Color fundus photograph from a handheld portable camera — 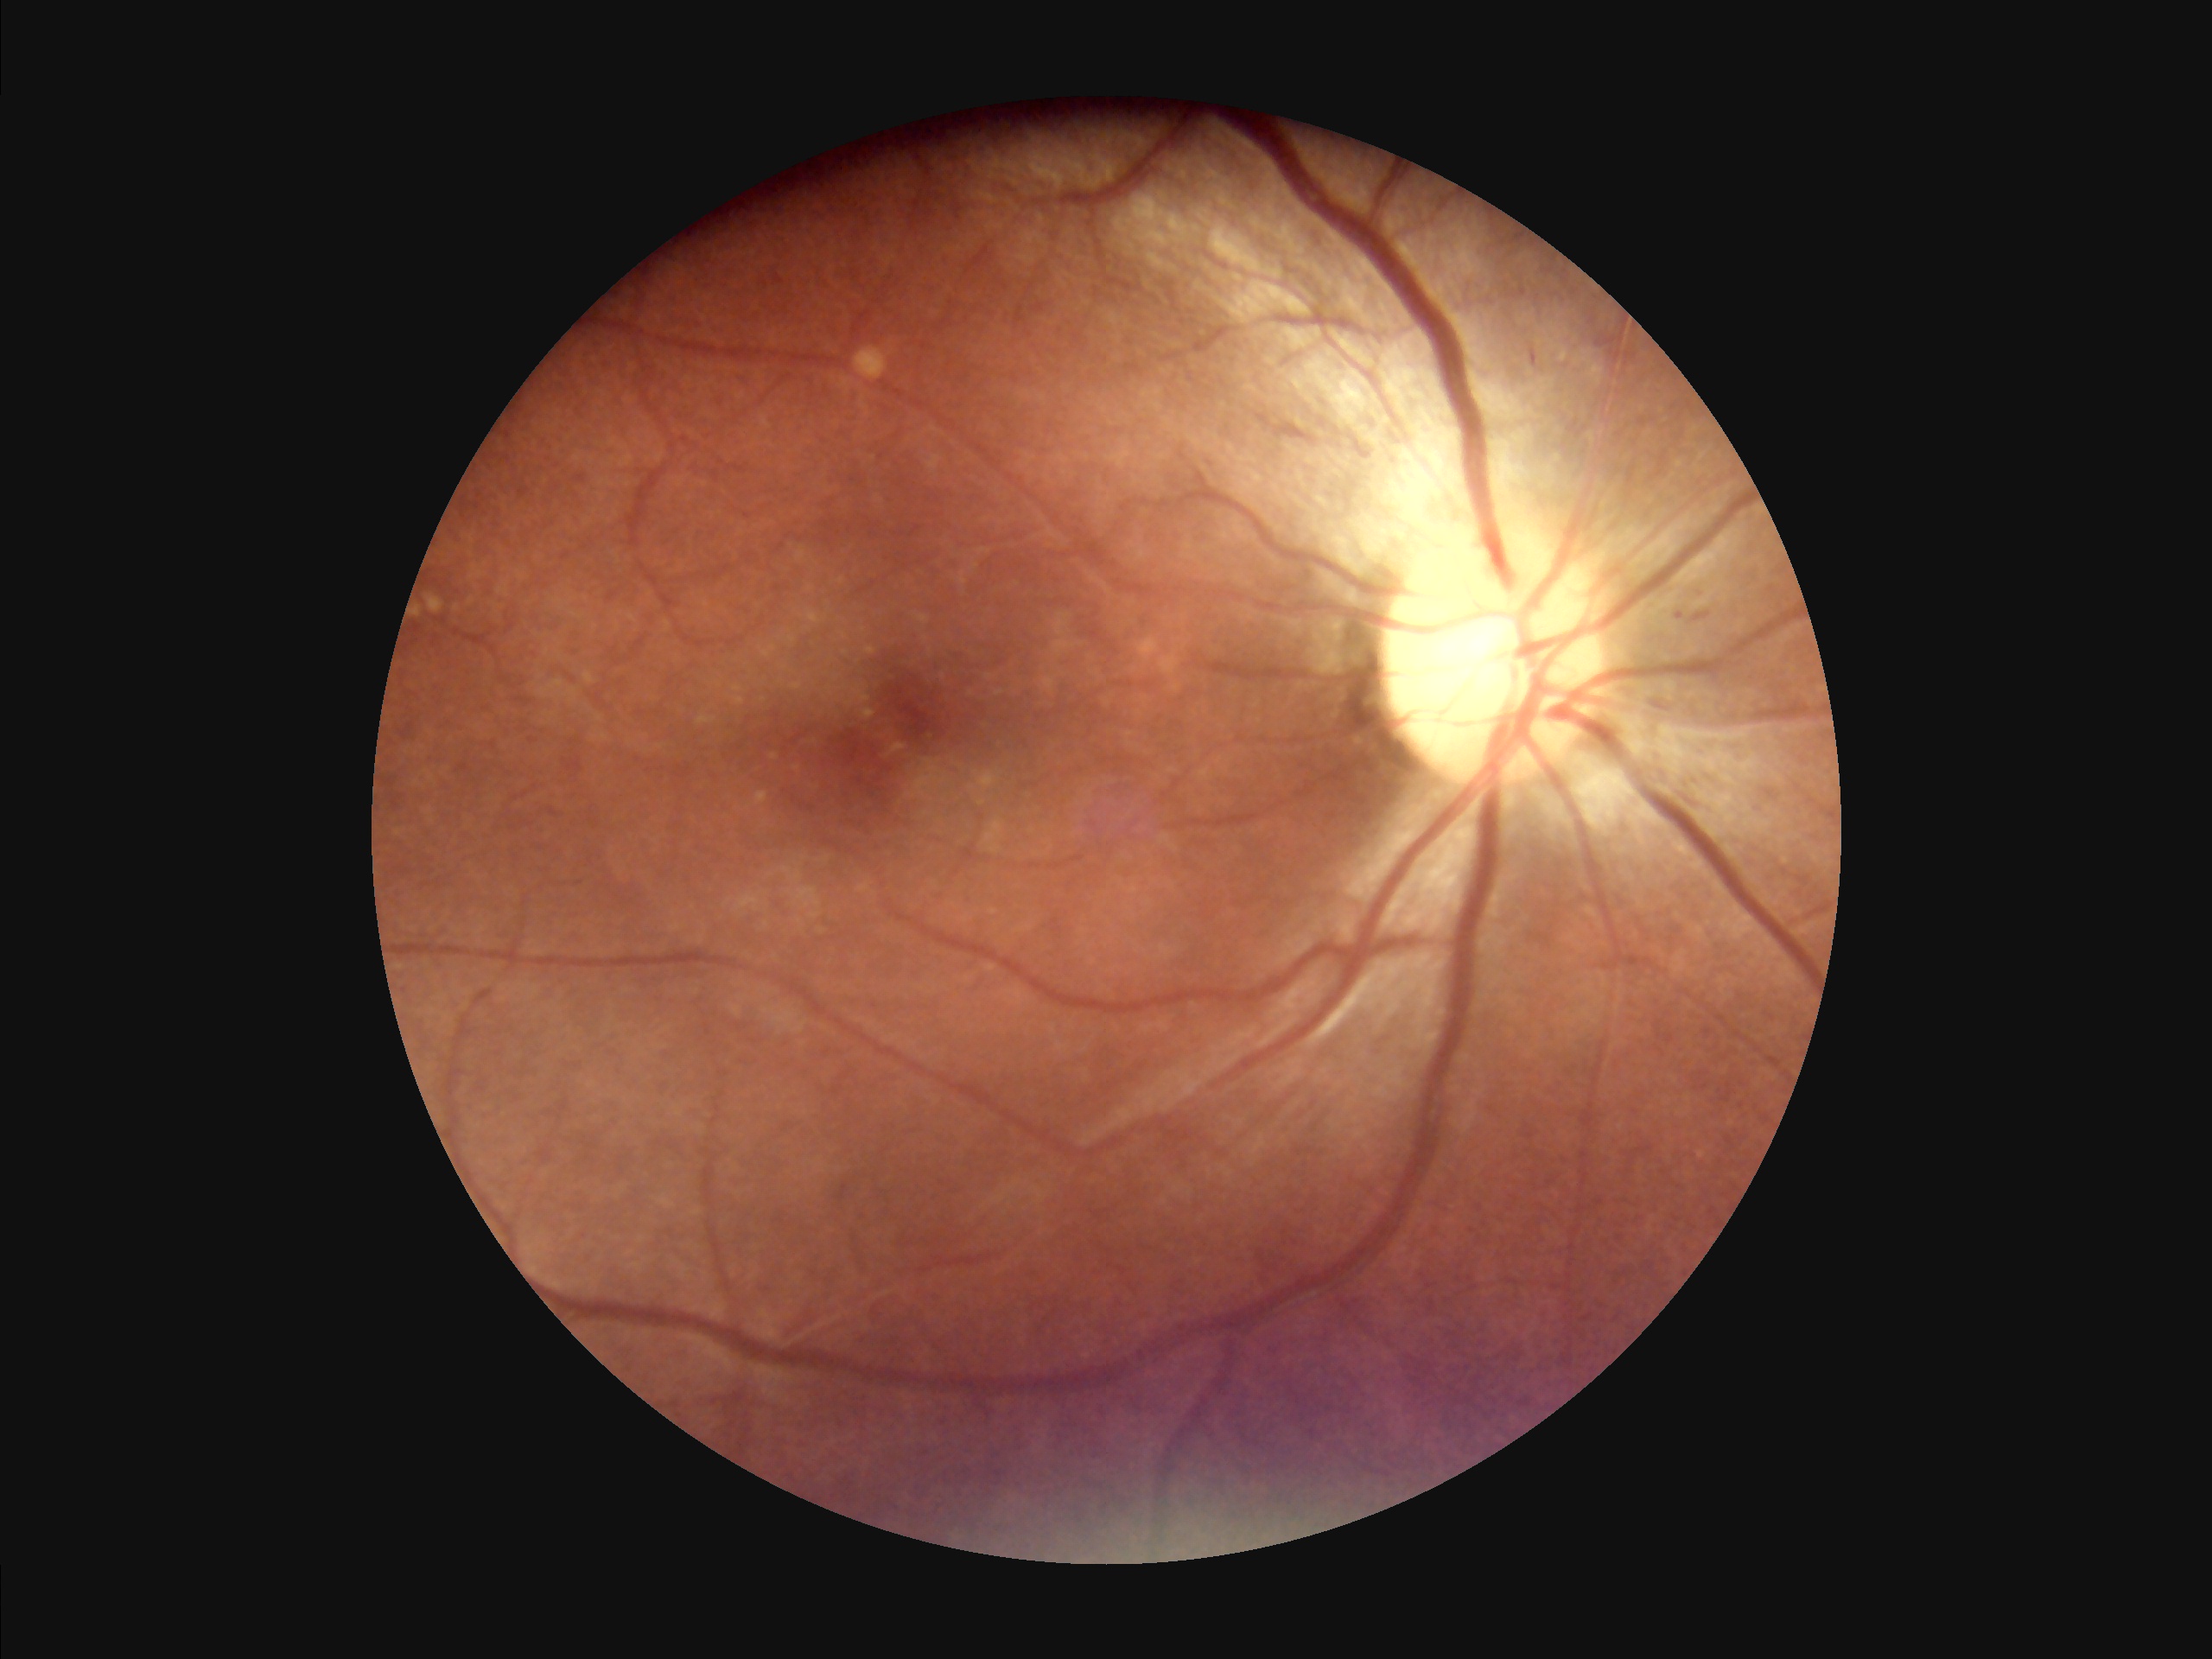

{"overall_quality": "adequate for clinical interpretation", "clarity": "optic disc, vessels, and background in focus"}